Modified Davis grading.
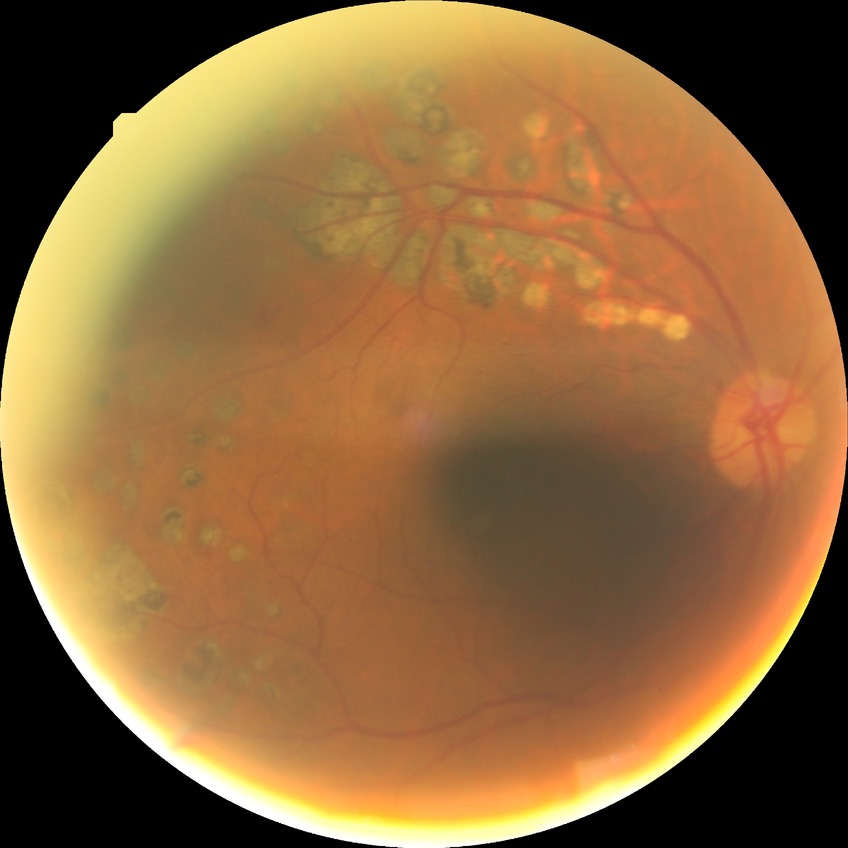

retinopathy grade = proliferative diabetic retinopathy.